Modified Davis grading.
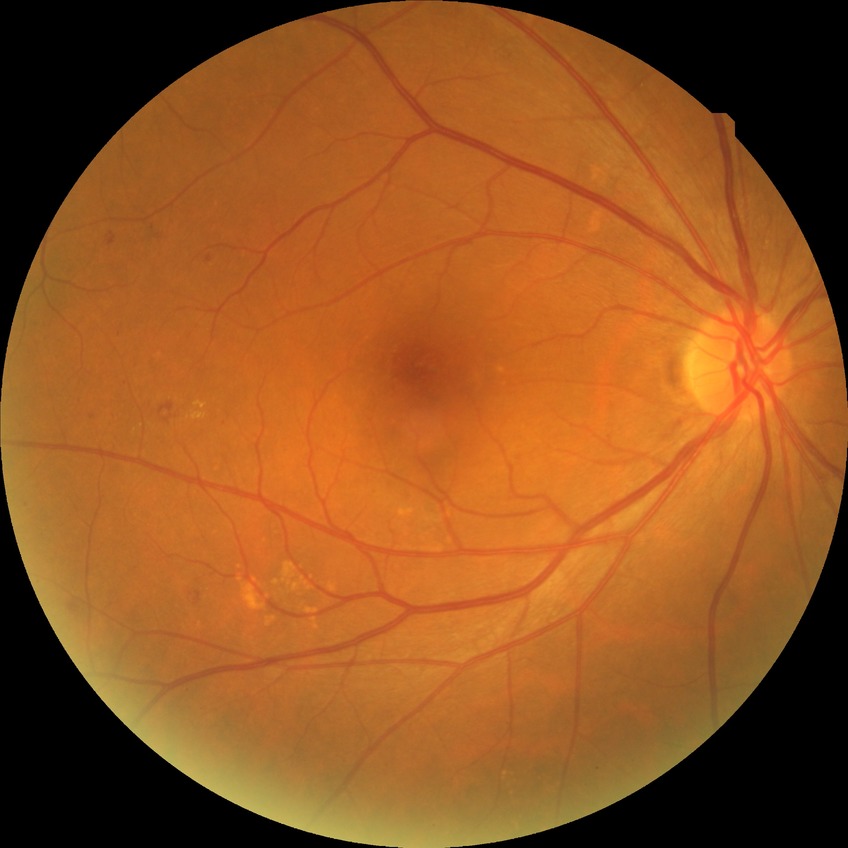 Diabetic retinopathy (DR) is SDR (simple diabetic retinopathy).